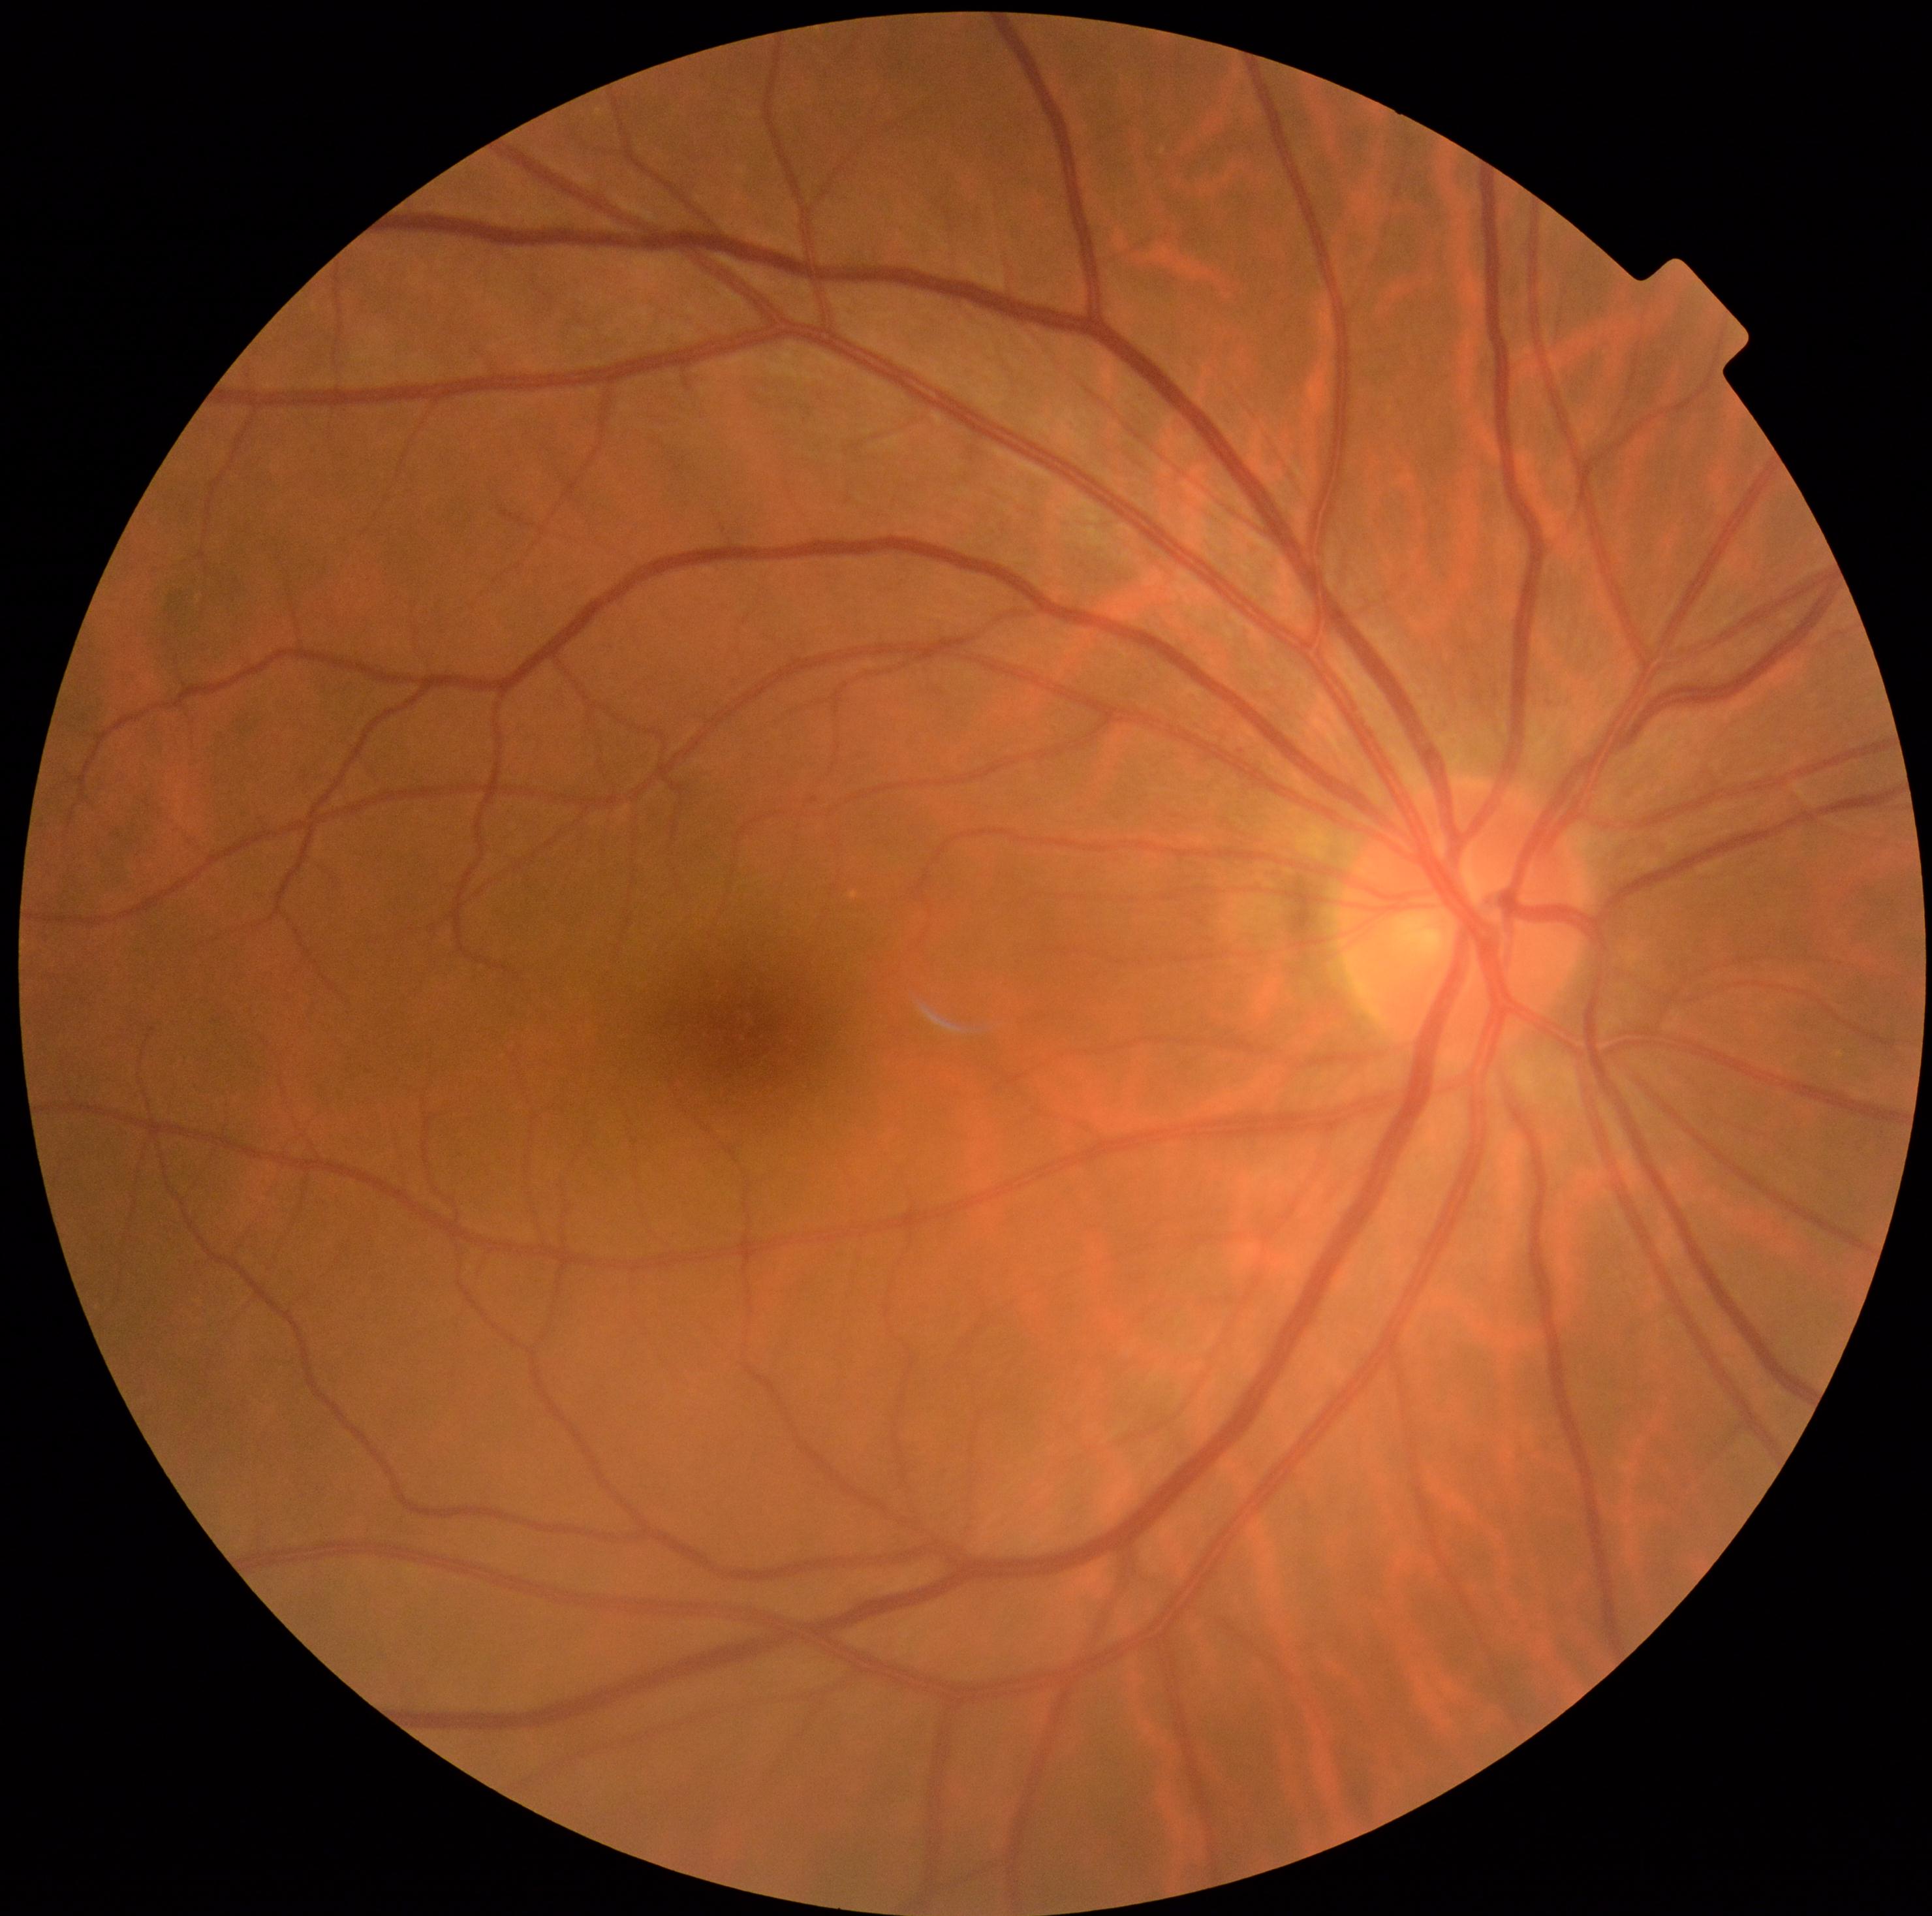 DR severity = grade 0 (no apparent retinopathy).